2048x1536
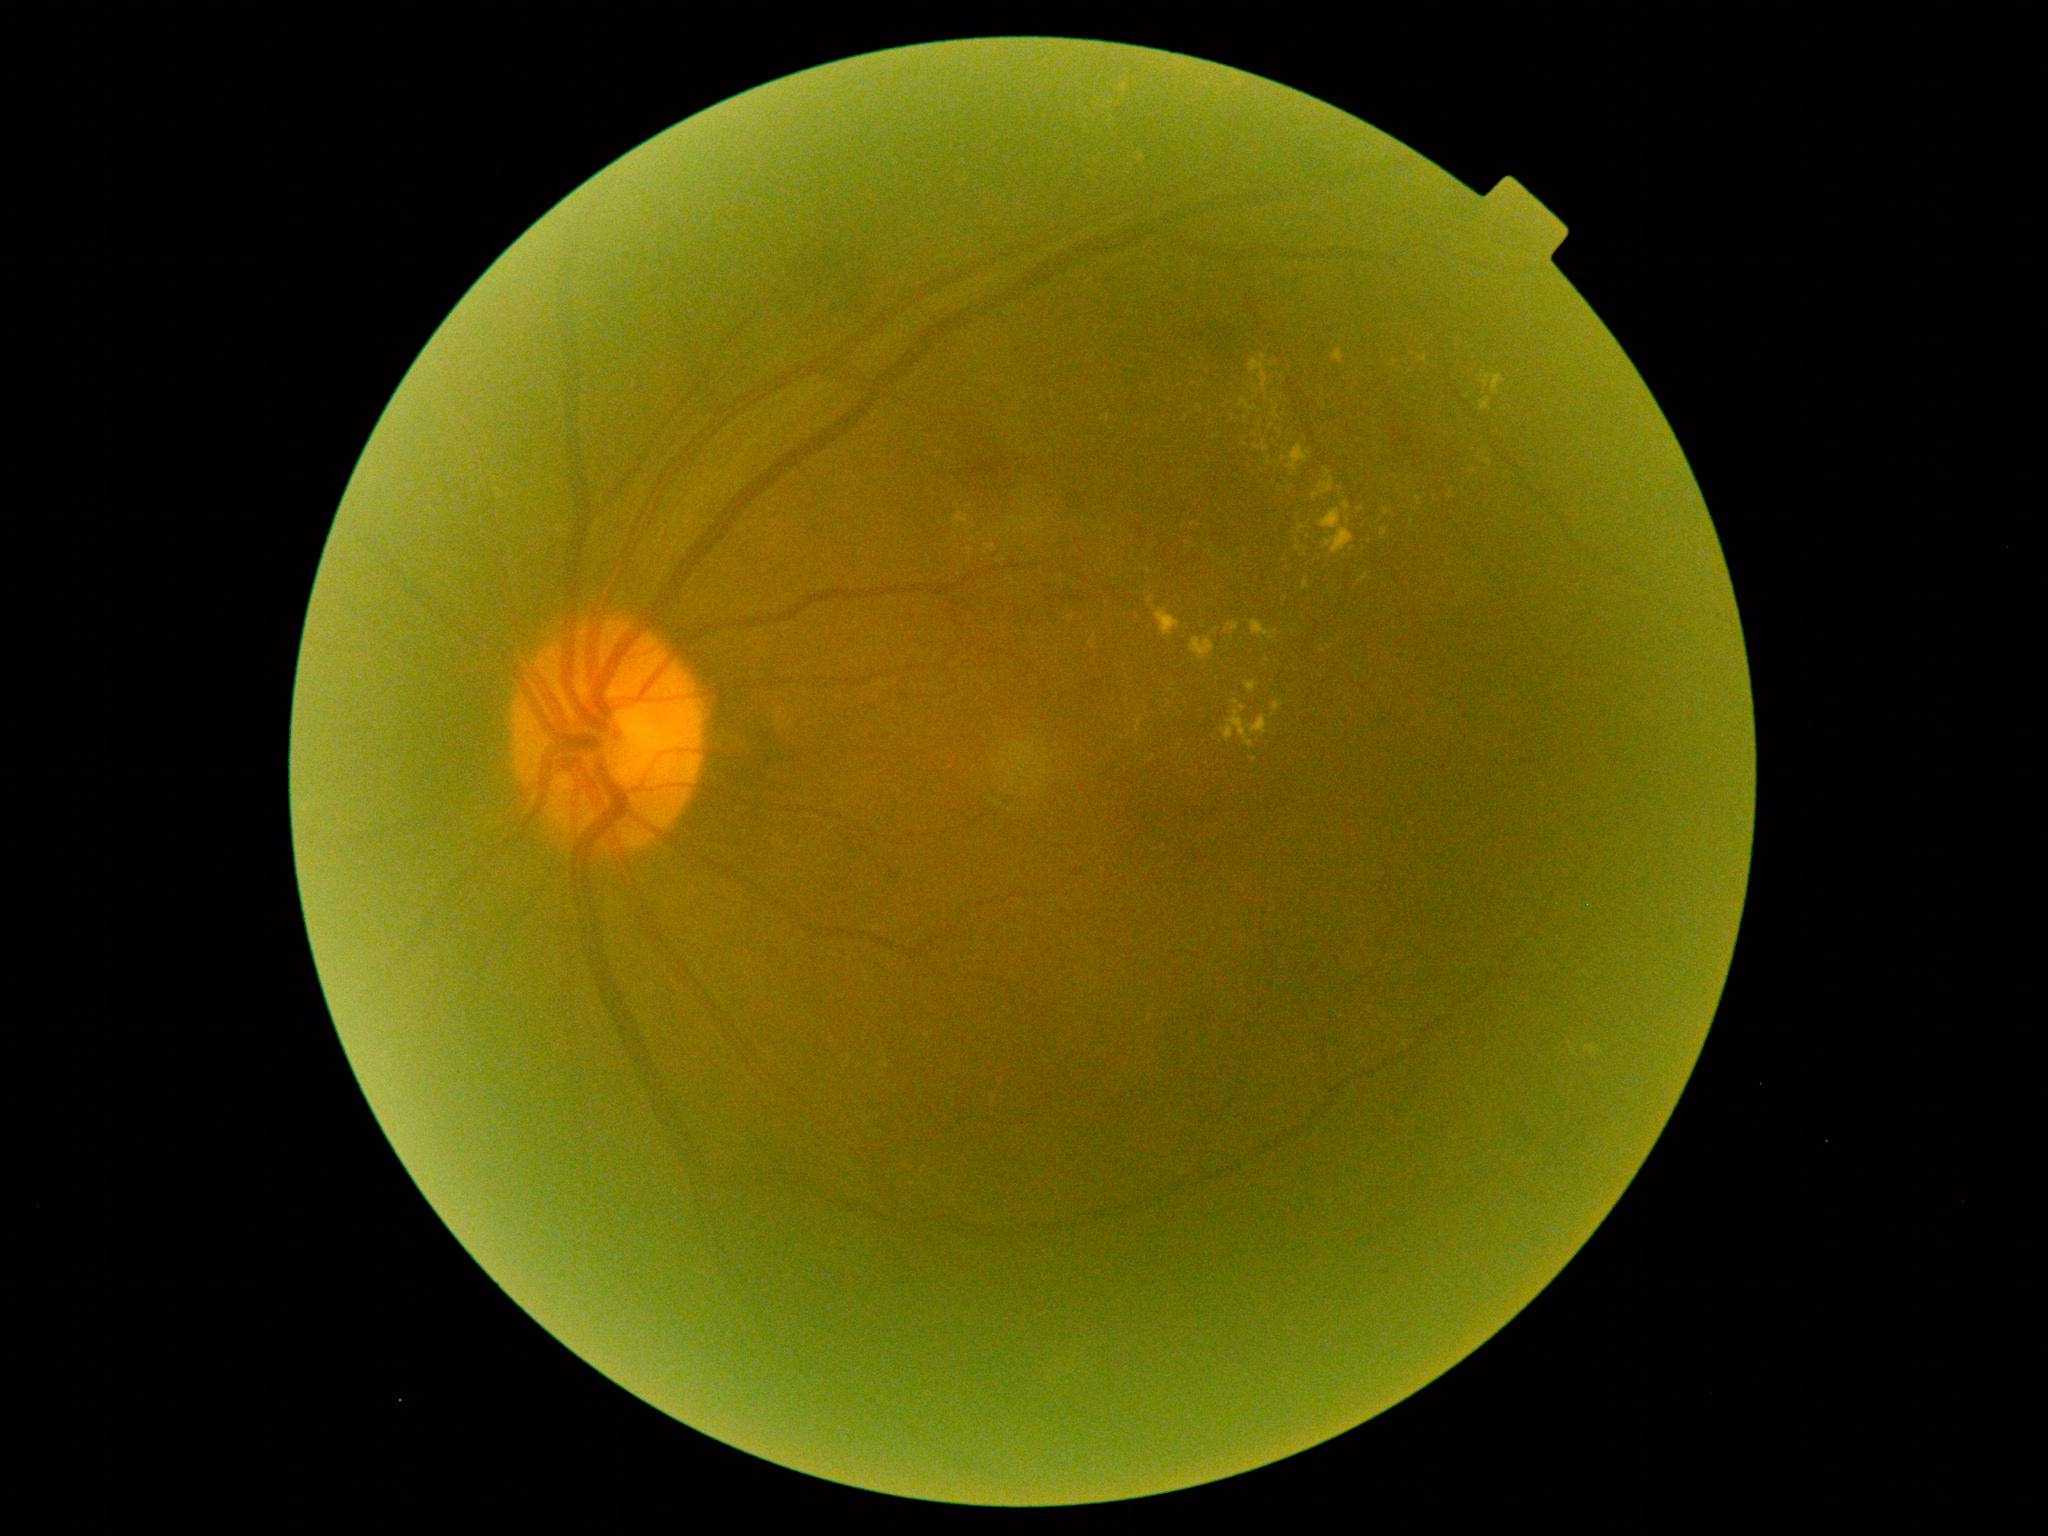 DR: moderate non-proliferative diabetic retinopathy (grade 2).